Fundus photo · 2352x1568px · 45° field of view.
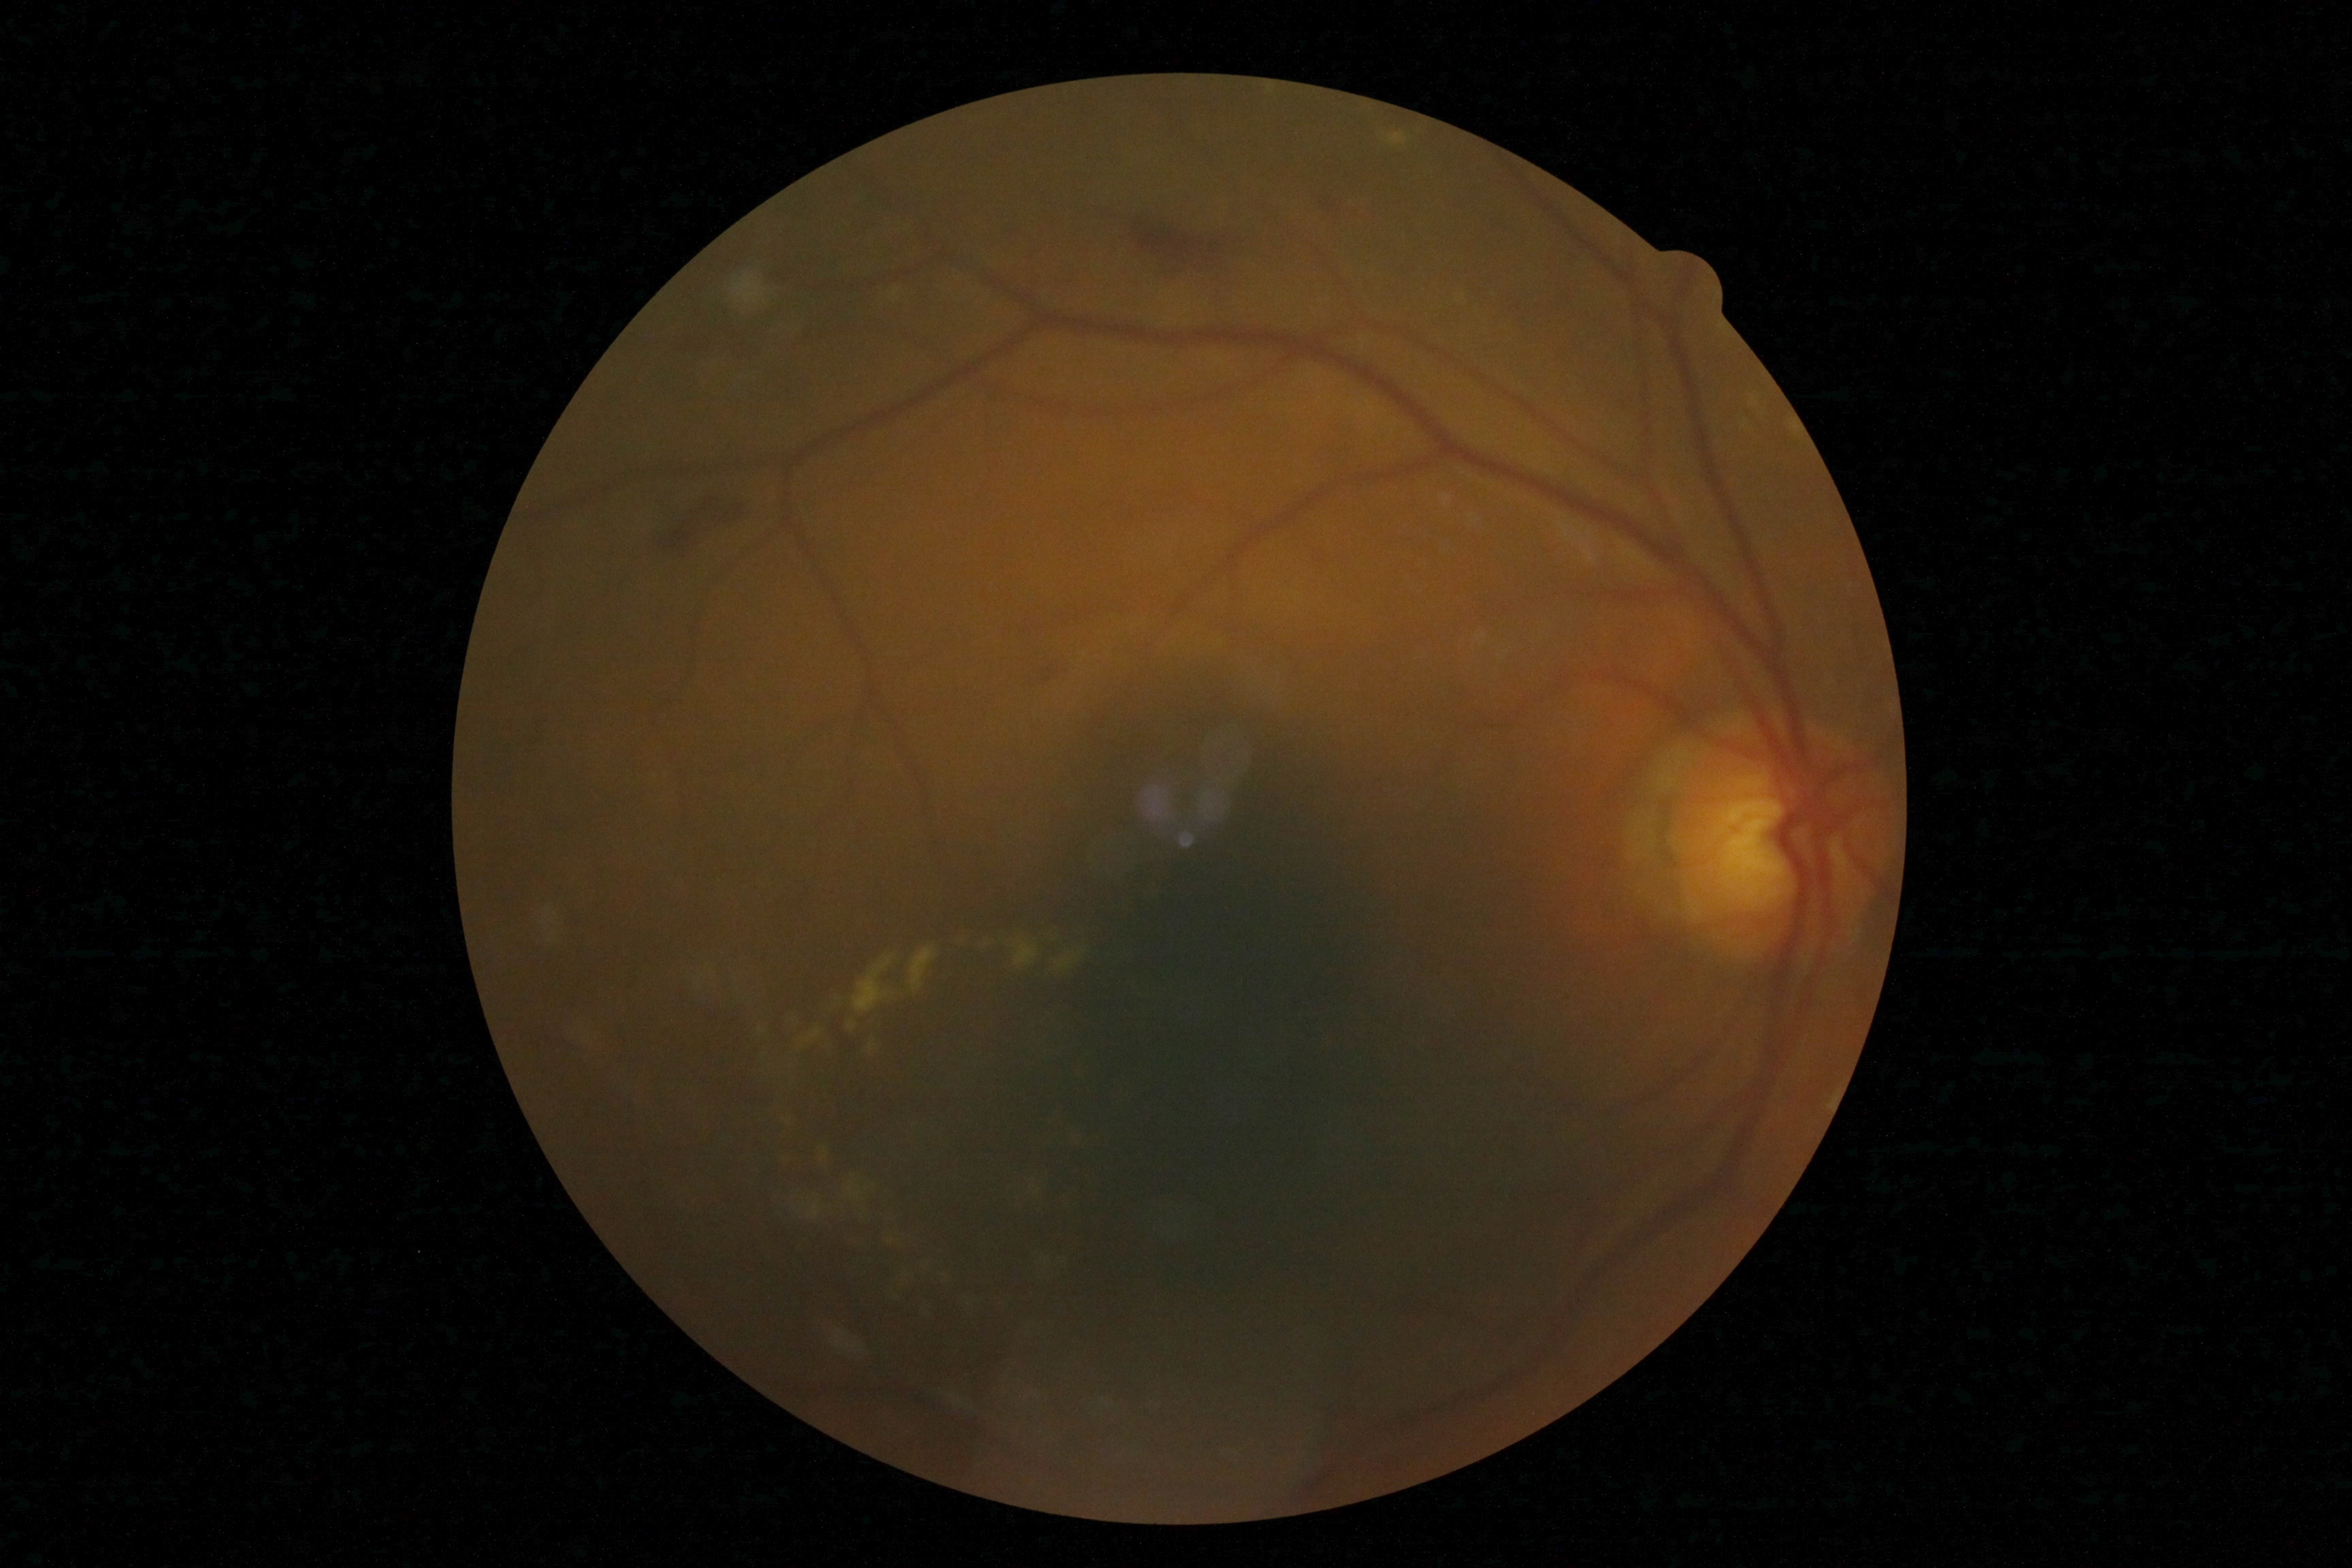 Diabetic retinopathy (DR): moderate NPDR (grade 2).